848 by 848 pixels, 45-degree field of view, CFP:
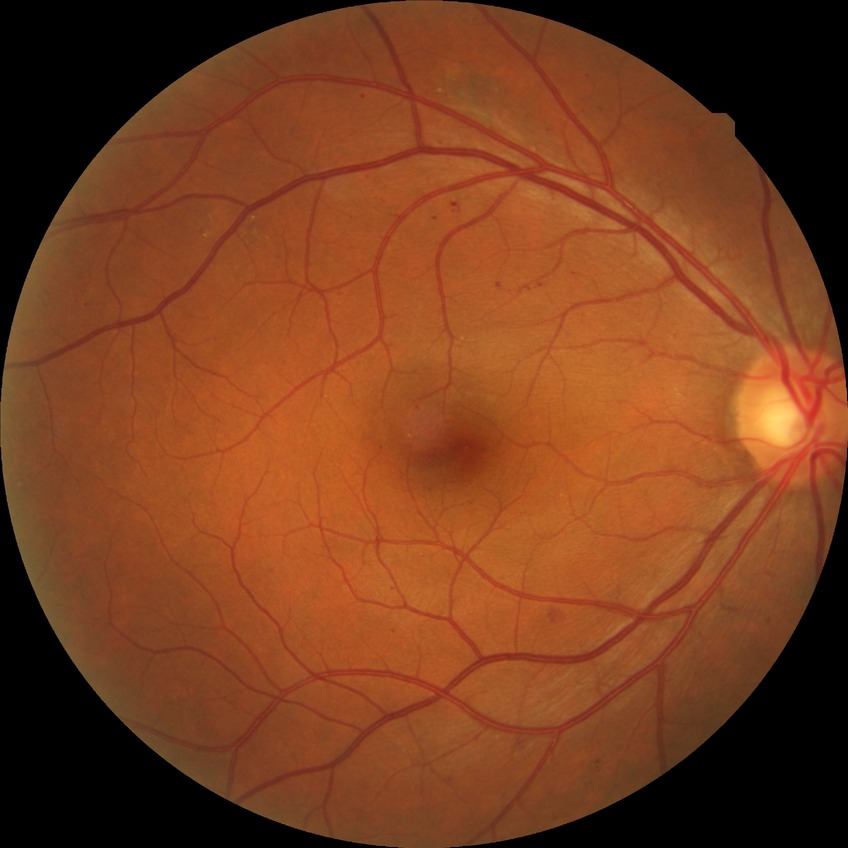
Diabetic retinopathy (DR) is SDR (simple diabetic retinopathy).